FOV: 45 degrees; 2212x1659px:
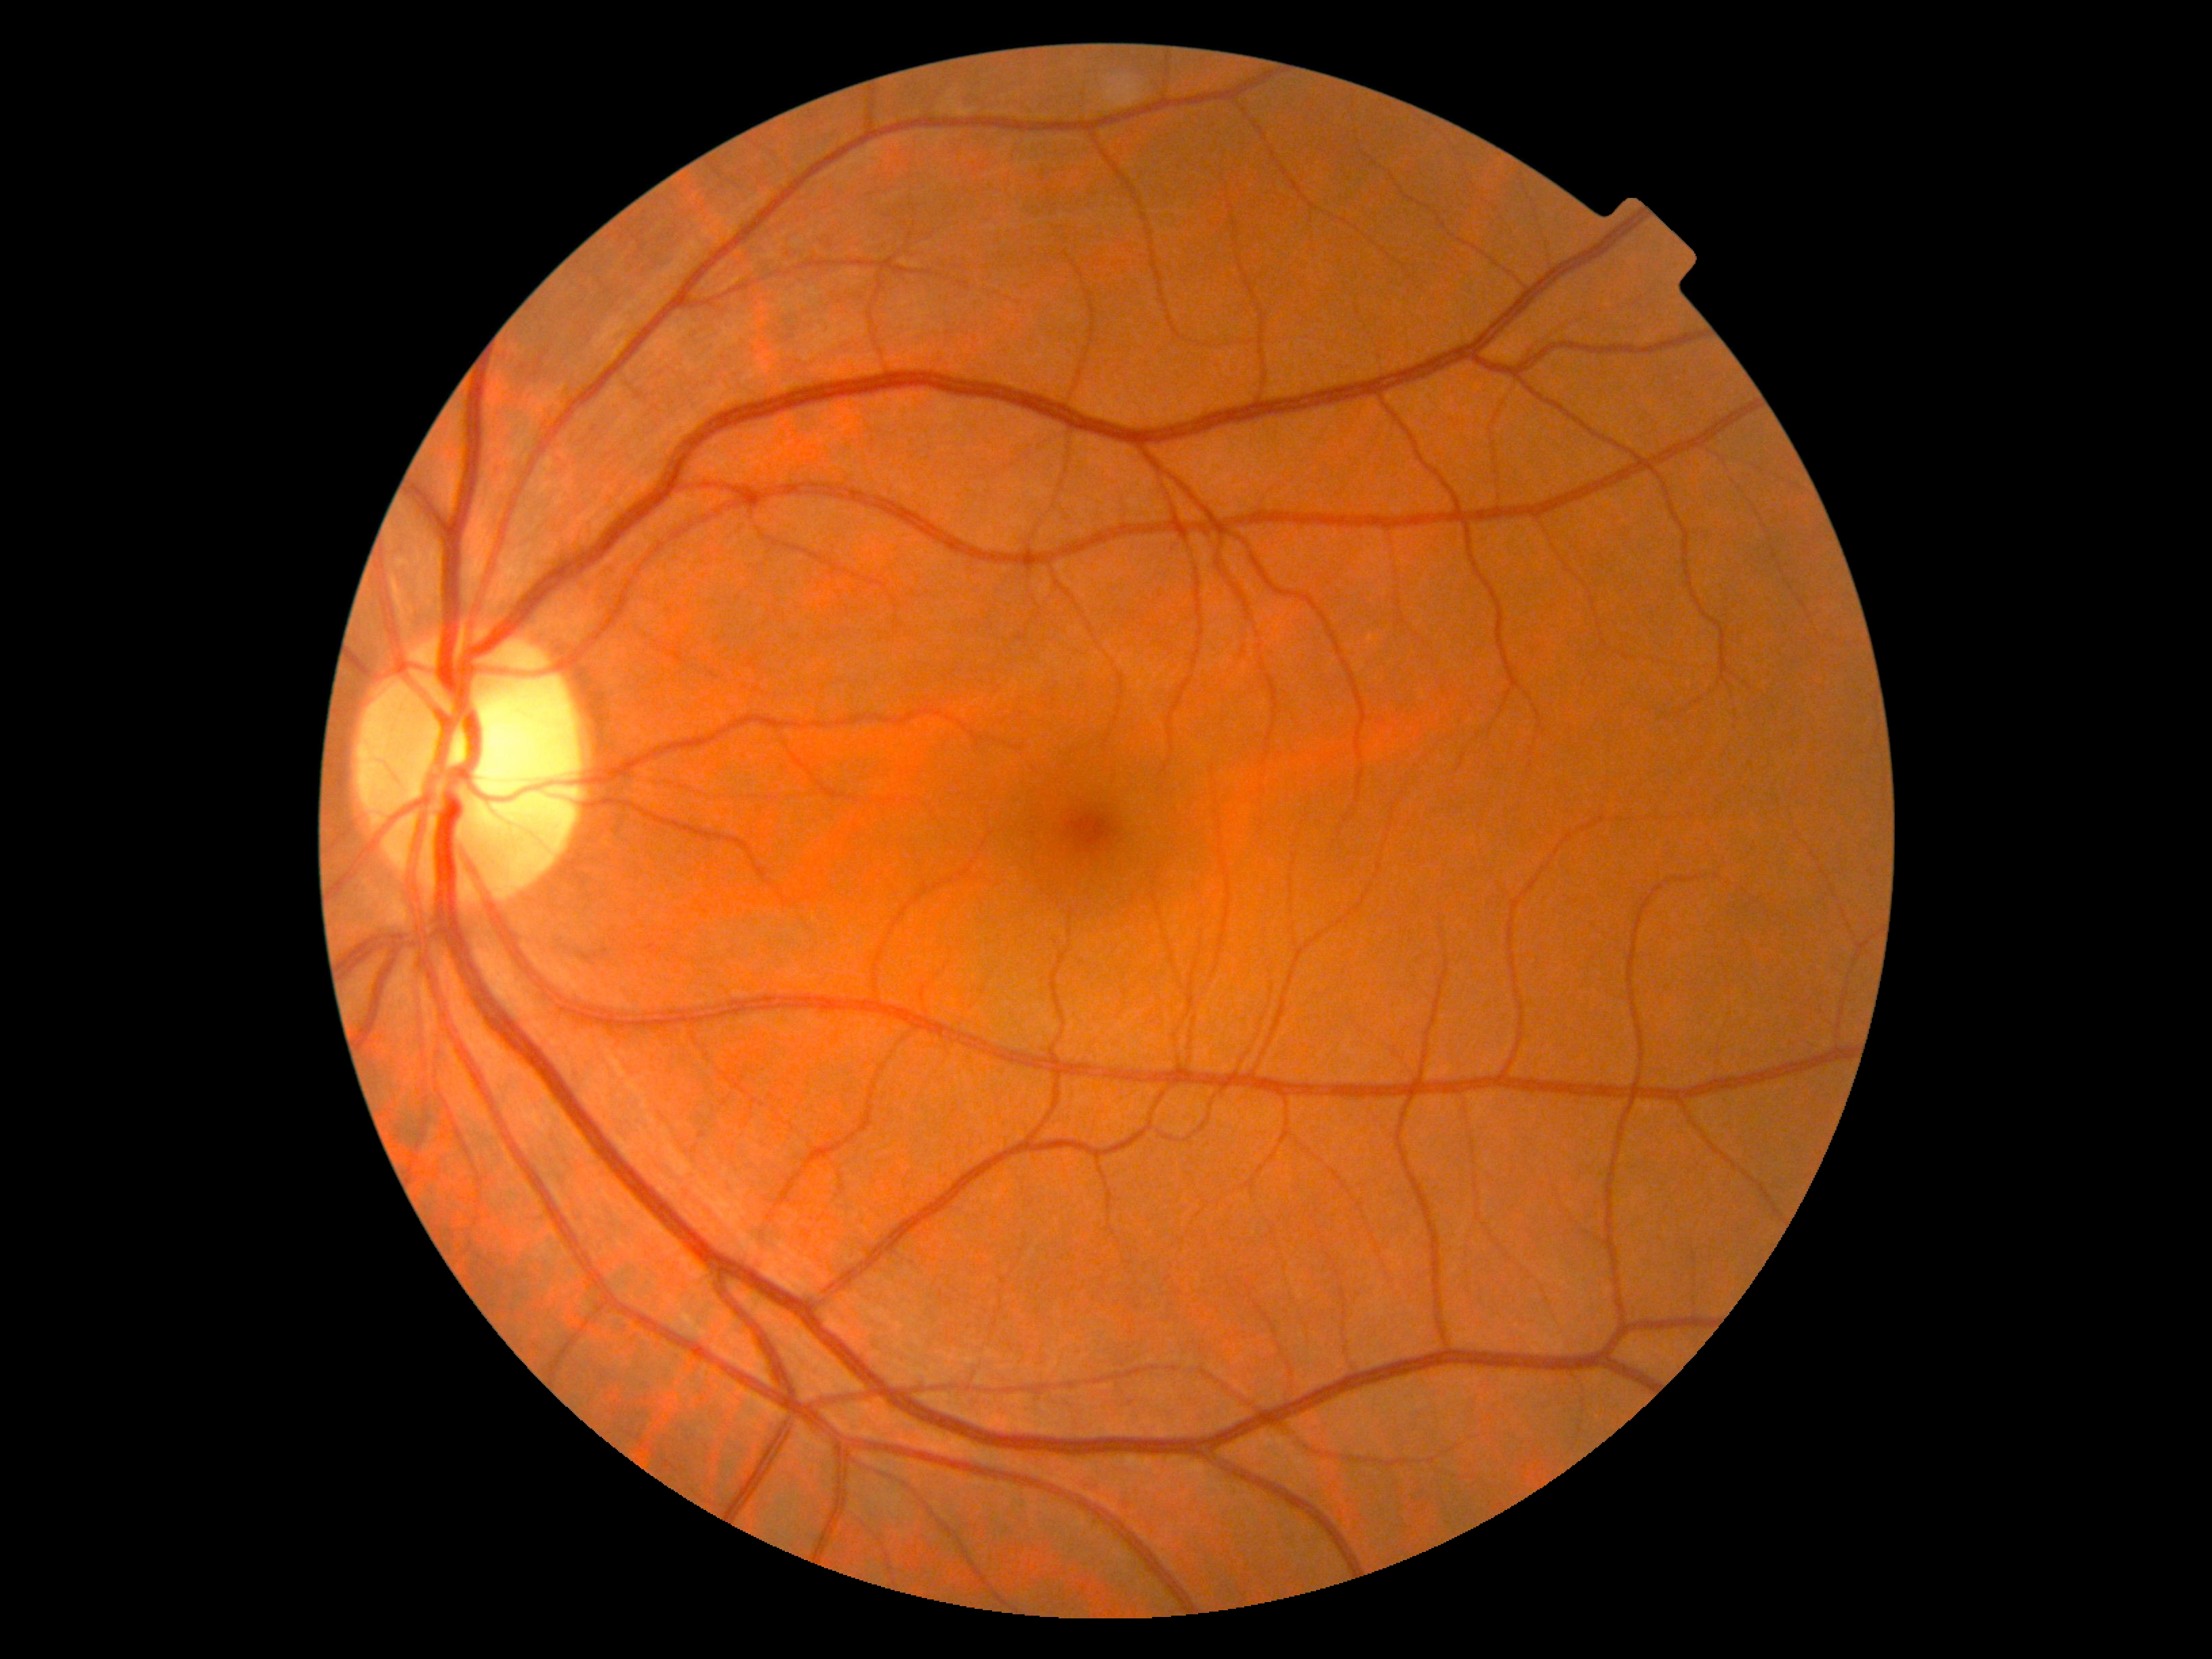
Retinopathy is 0/4.